45° FOV; acquired with a NIDEK AFC-230; modified Davis classification; retinal fundus photograph.
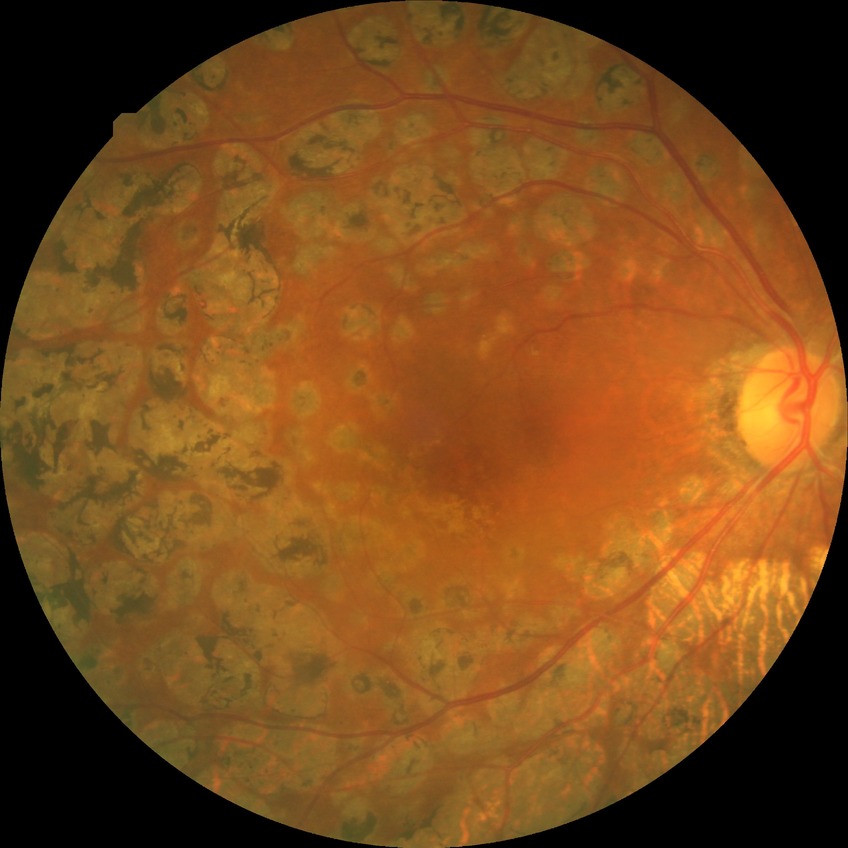   davis_grade: PDR